Retinal fundus photograph · 2048x1536: 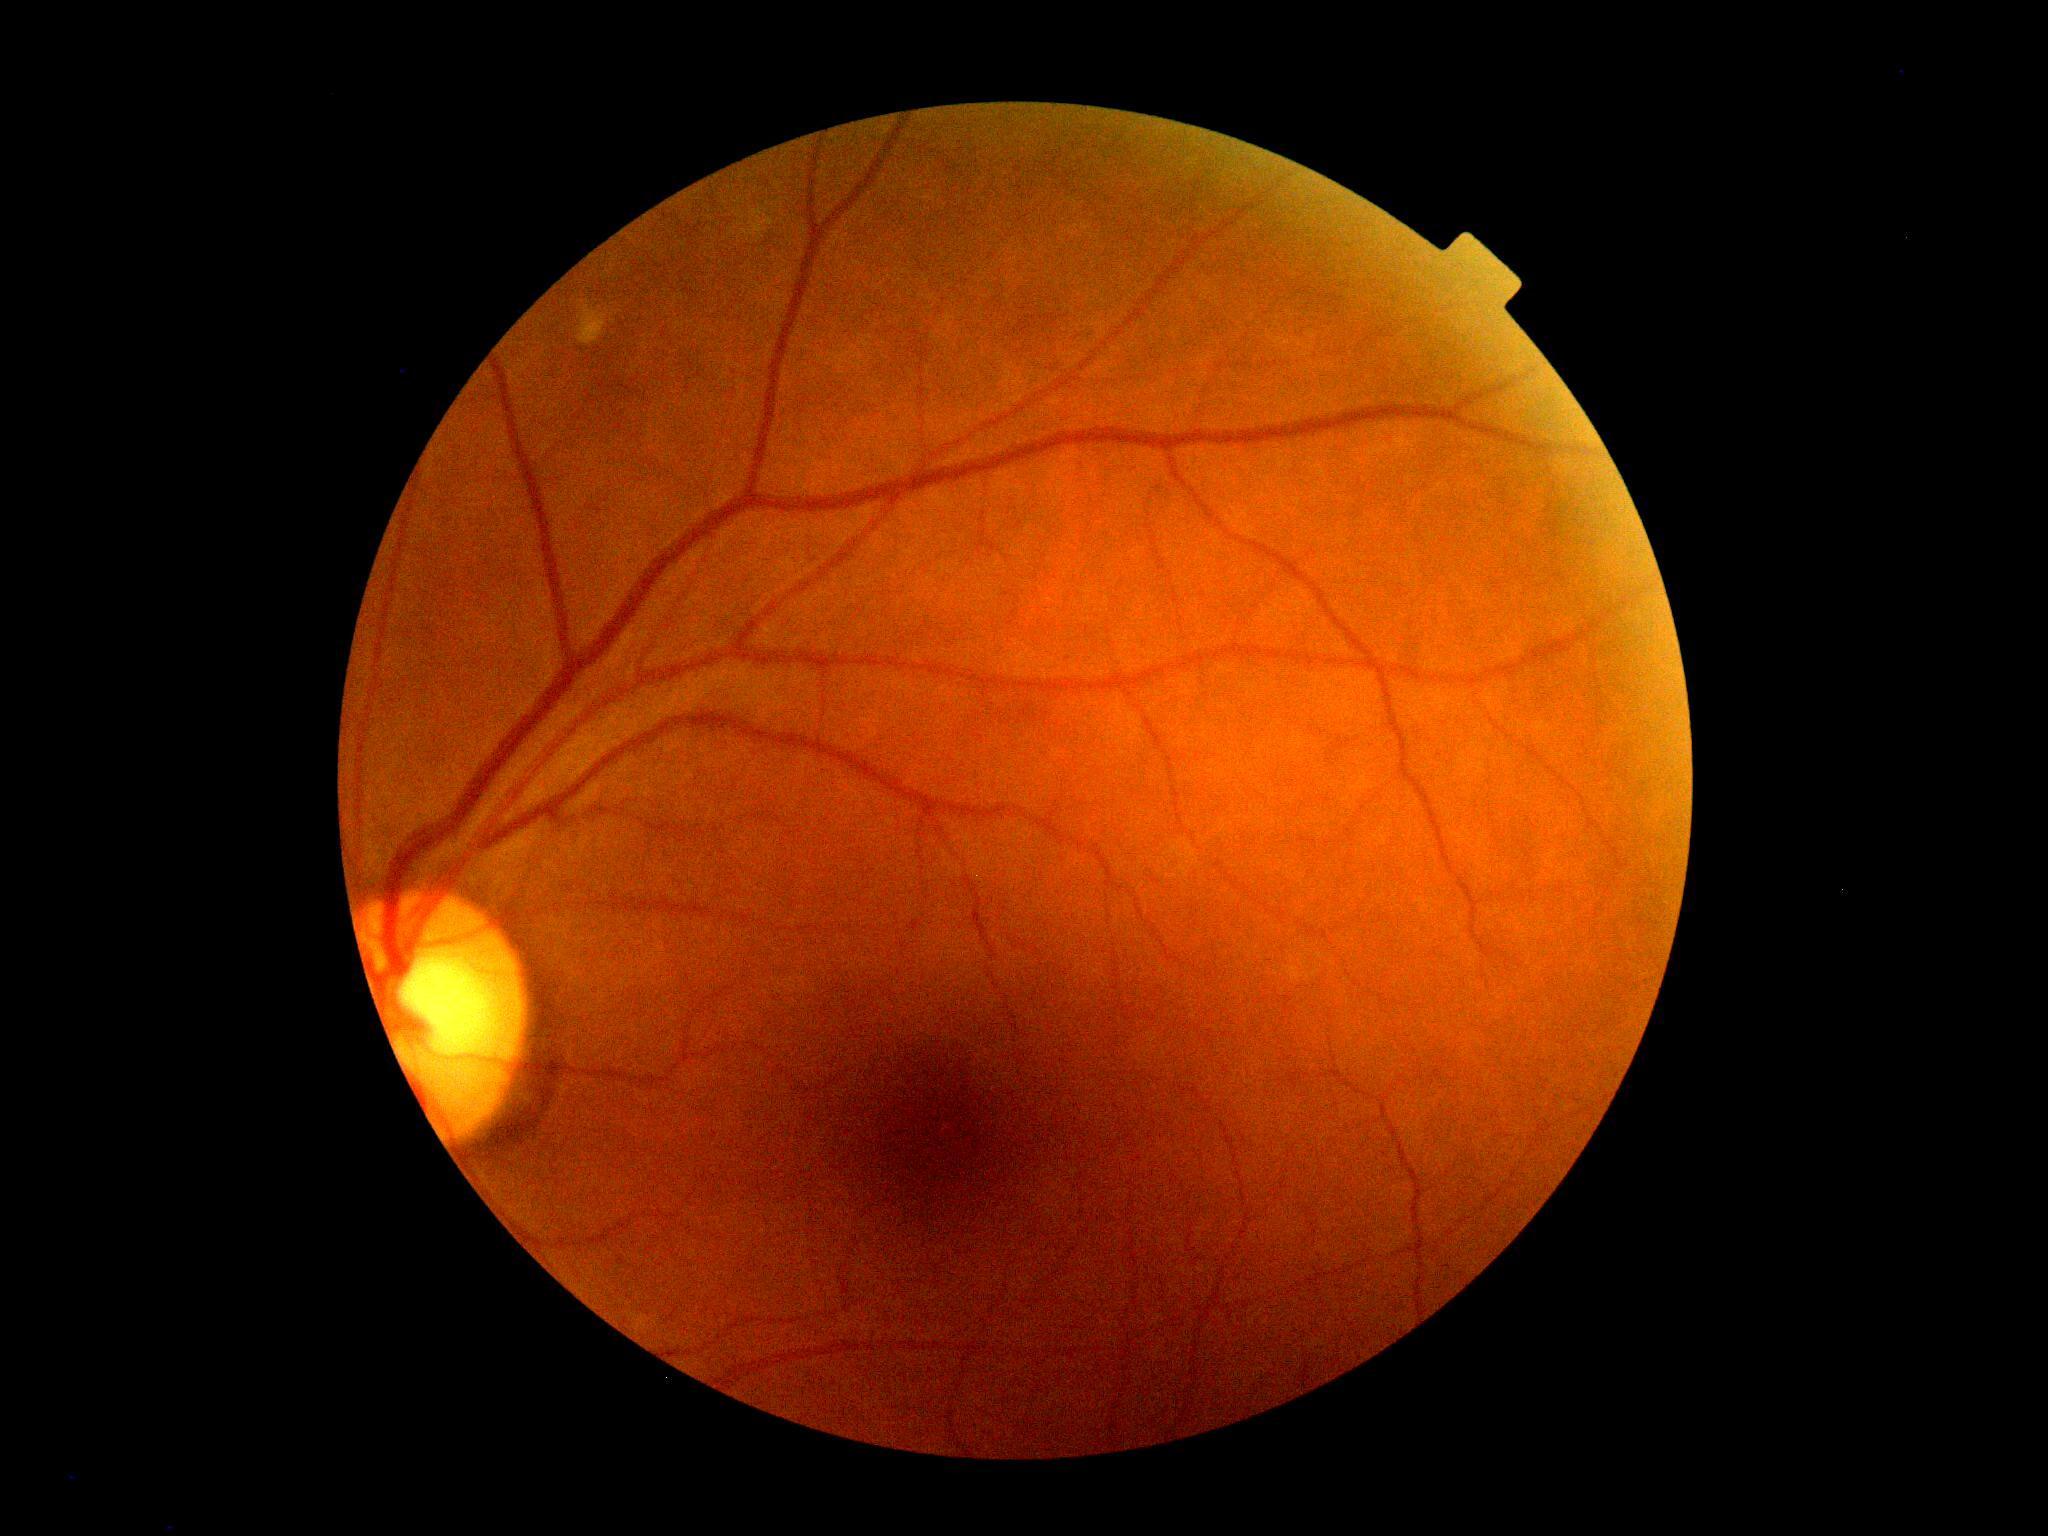 Diabetic retinopathy grade: no apparent retinopathy (0).